Wide-field contact fundus photograph of an infant. Clarity RetCam 3, 130° FOV: 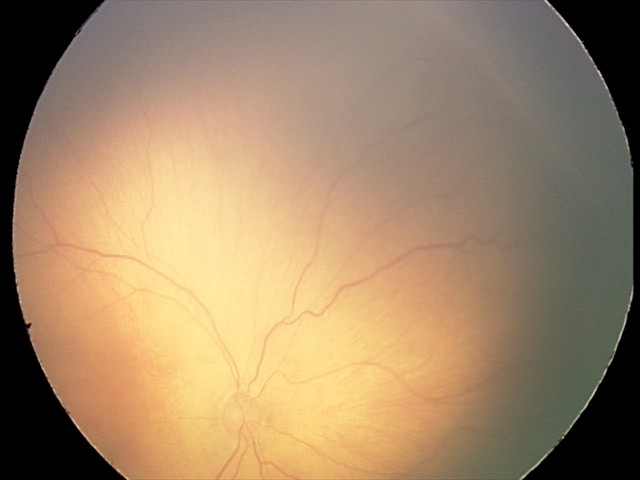

Examination diagnosed as ROP stage 2 — ridge with height and width at the demarcation line.
No plus disease.